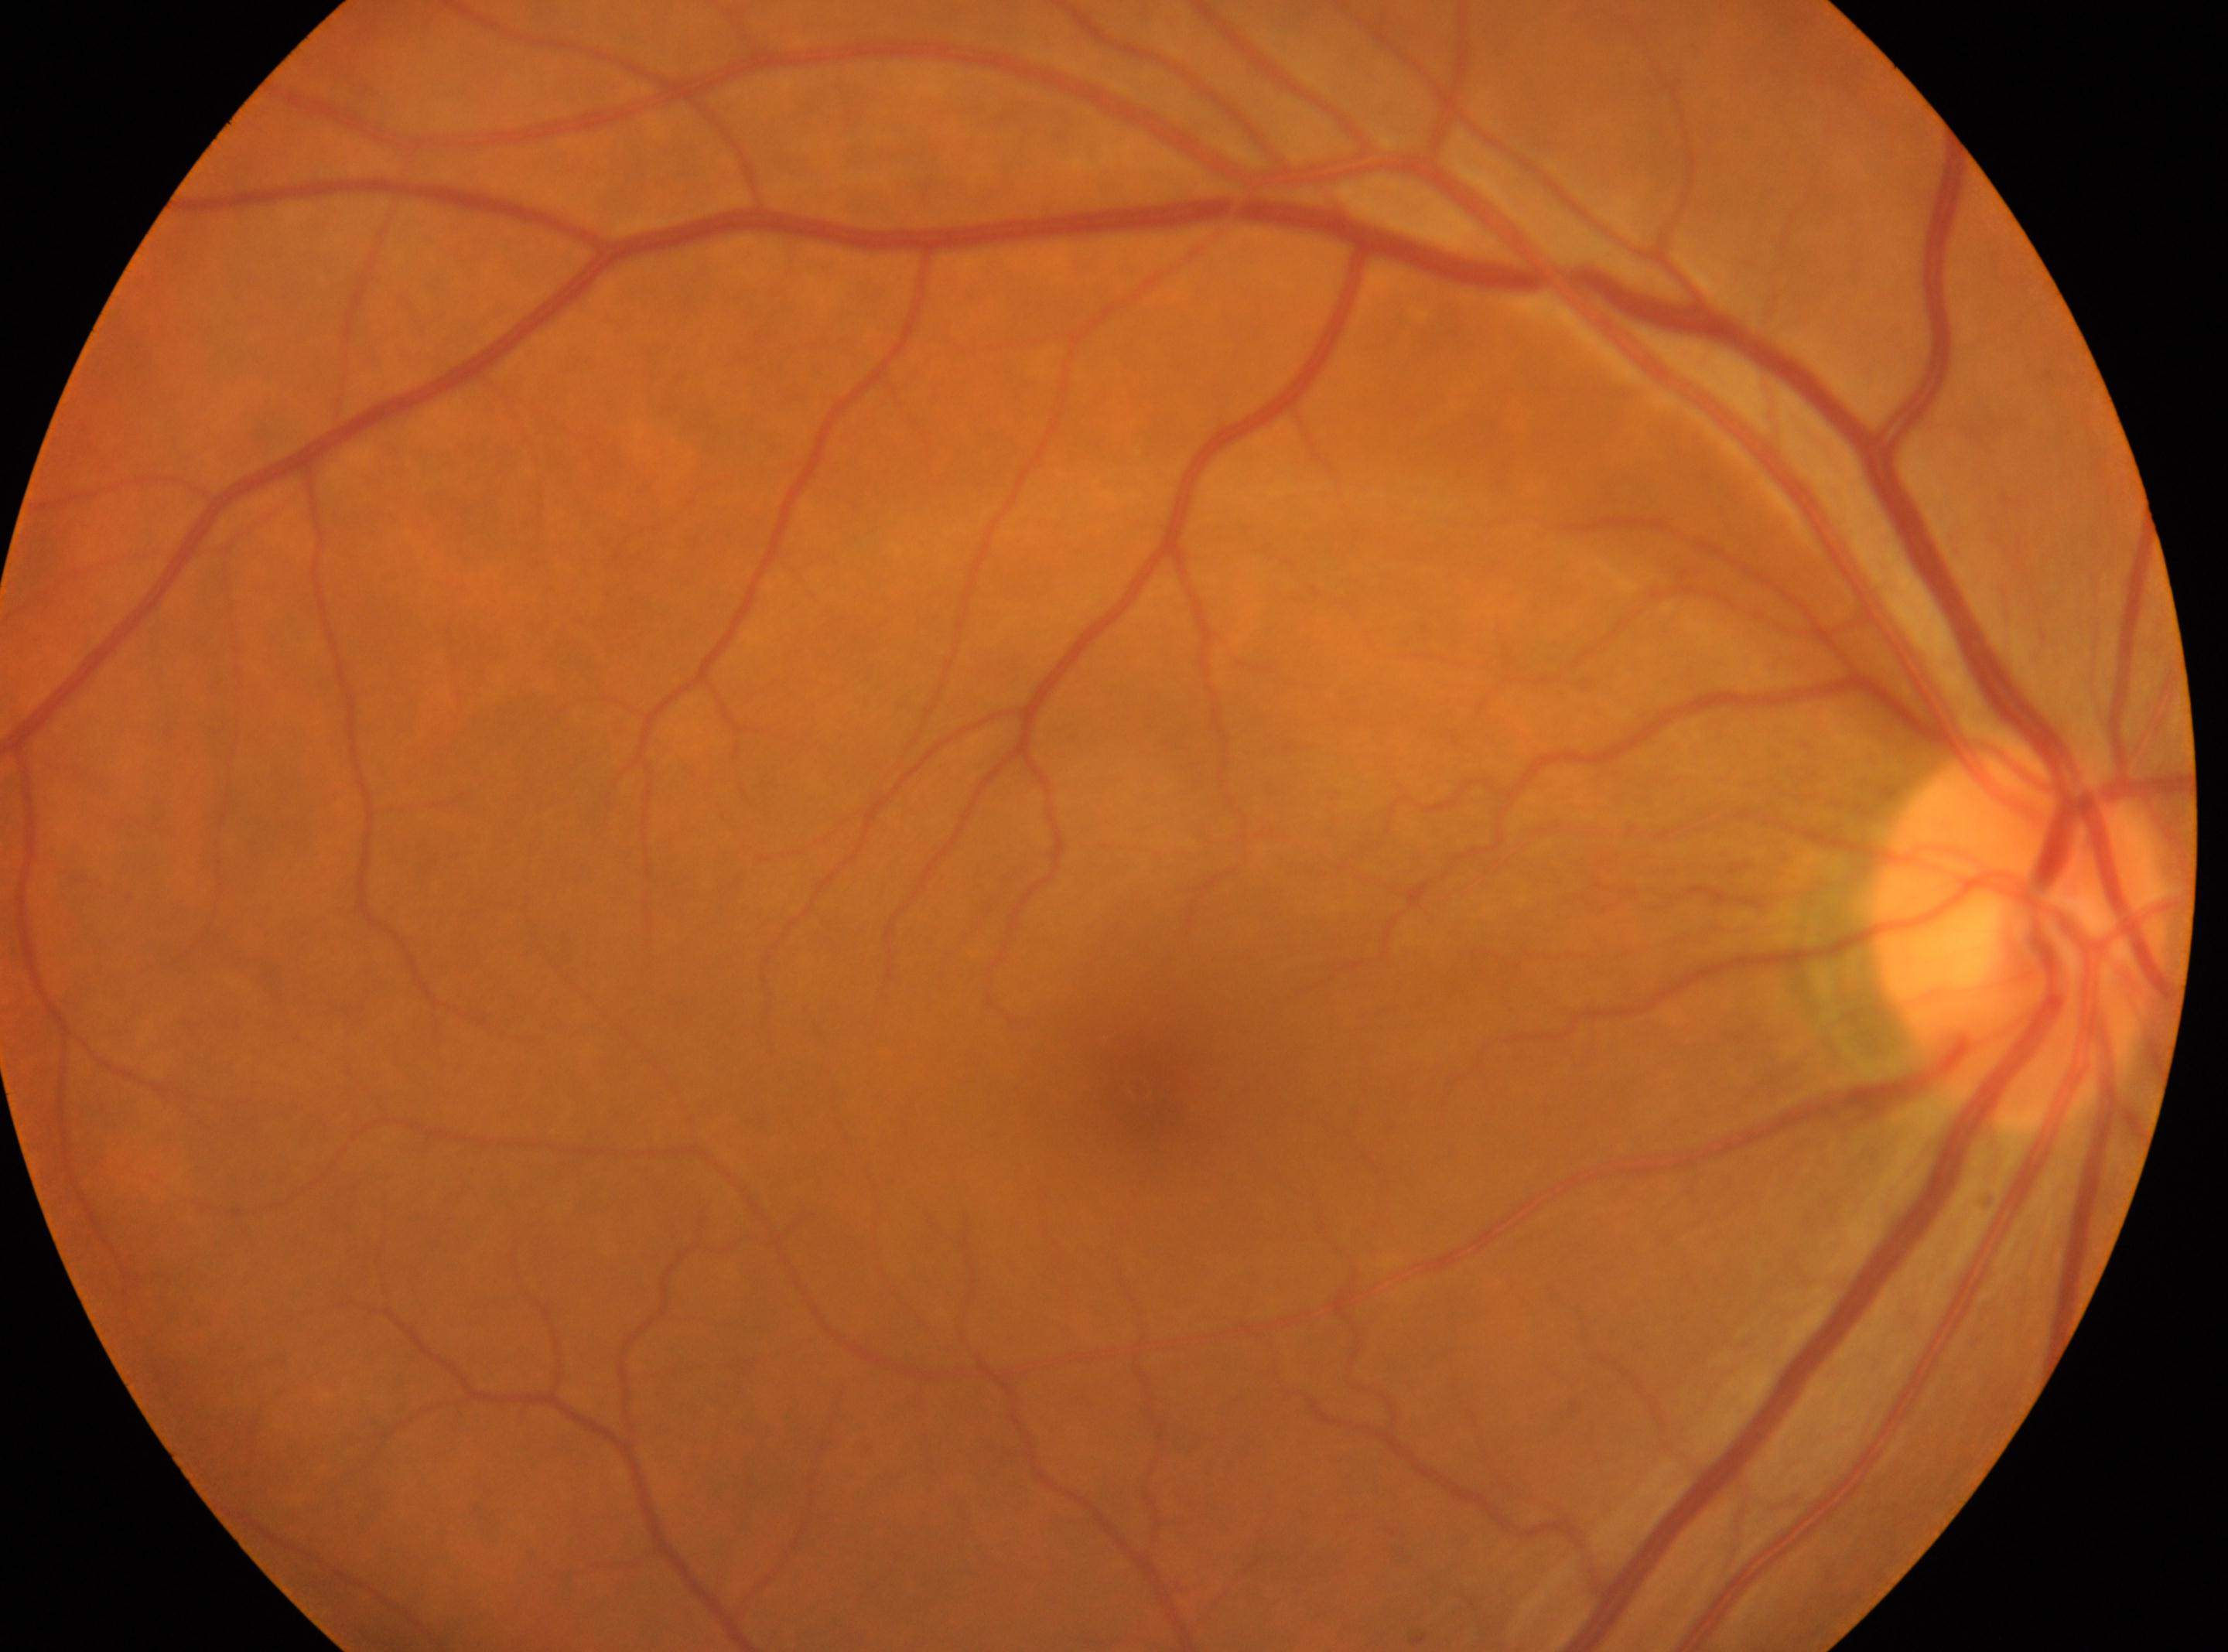

Diabetic retinopathy severity is no apparent retinopathy (grade 0).
Imaged eye: the right eye.
The optic disc is at 2021px, 934px.
Fovea centralis located at 1139px, 1087px.